Image size 1536x1152.
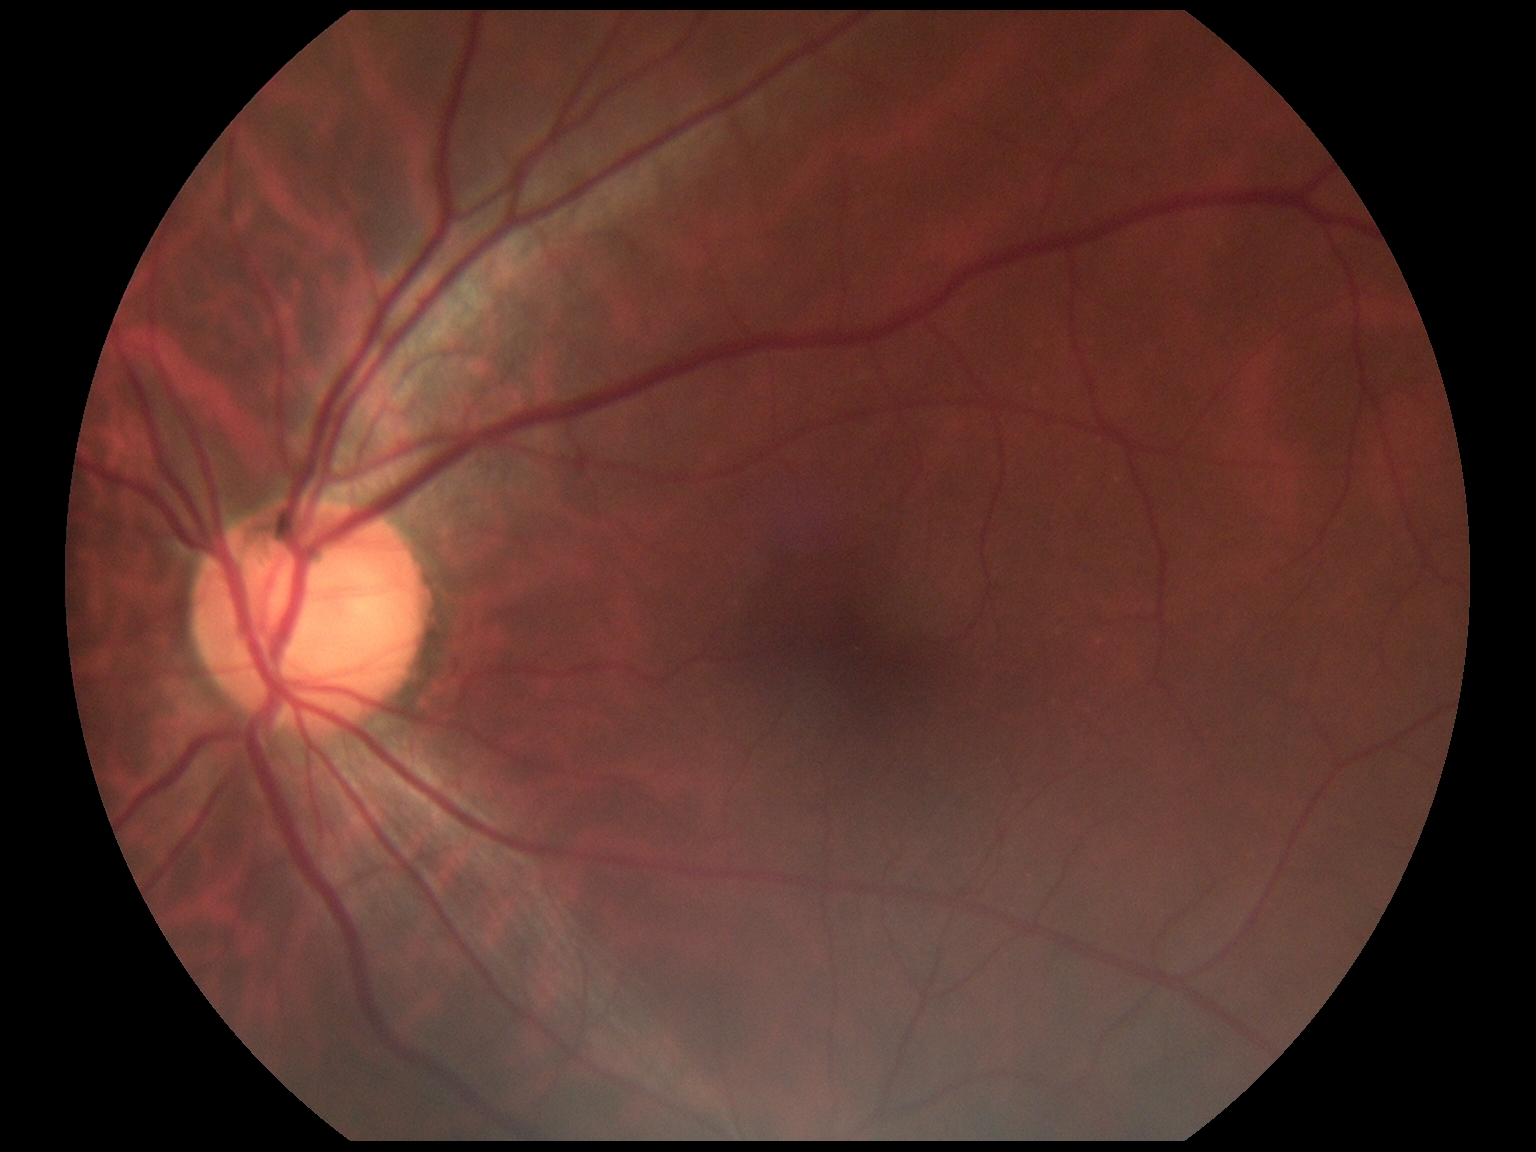
No apparent diabetic retinopathy. Diabetic retinopathy grade is 0 (no apparent retinopathy) — no visible signs of diabetic retinopathy.